Davis DR grading — 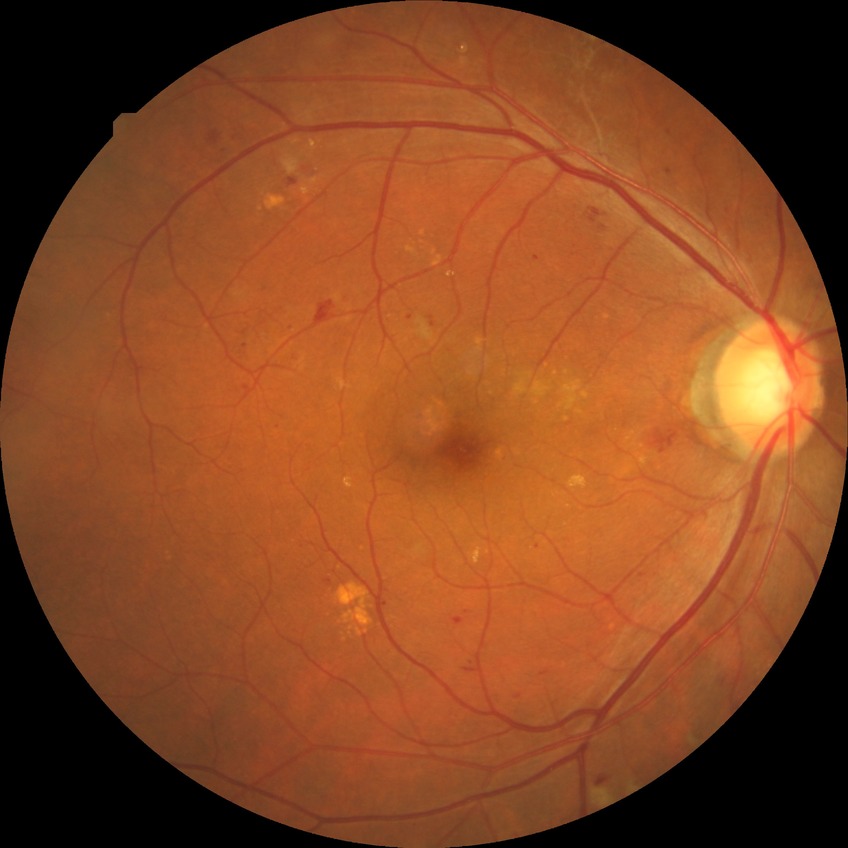

* diabetic retinopathy (DR): PPDR (pre-proliferative diabetic retinopathy)